2352x1568px · 45-degree field of view.
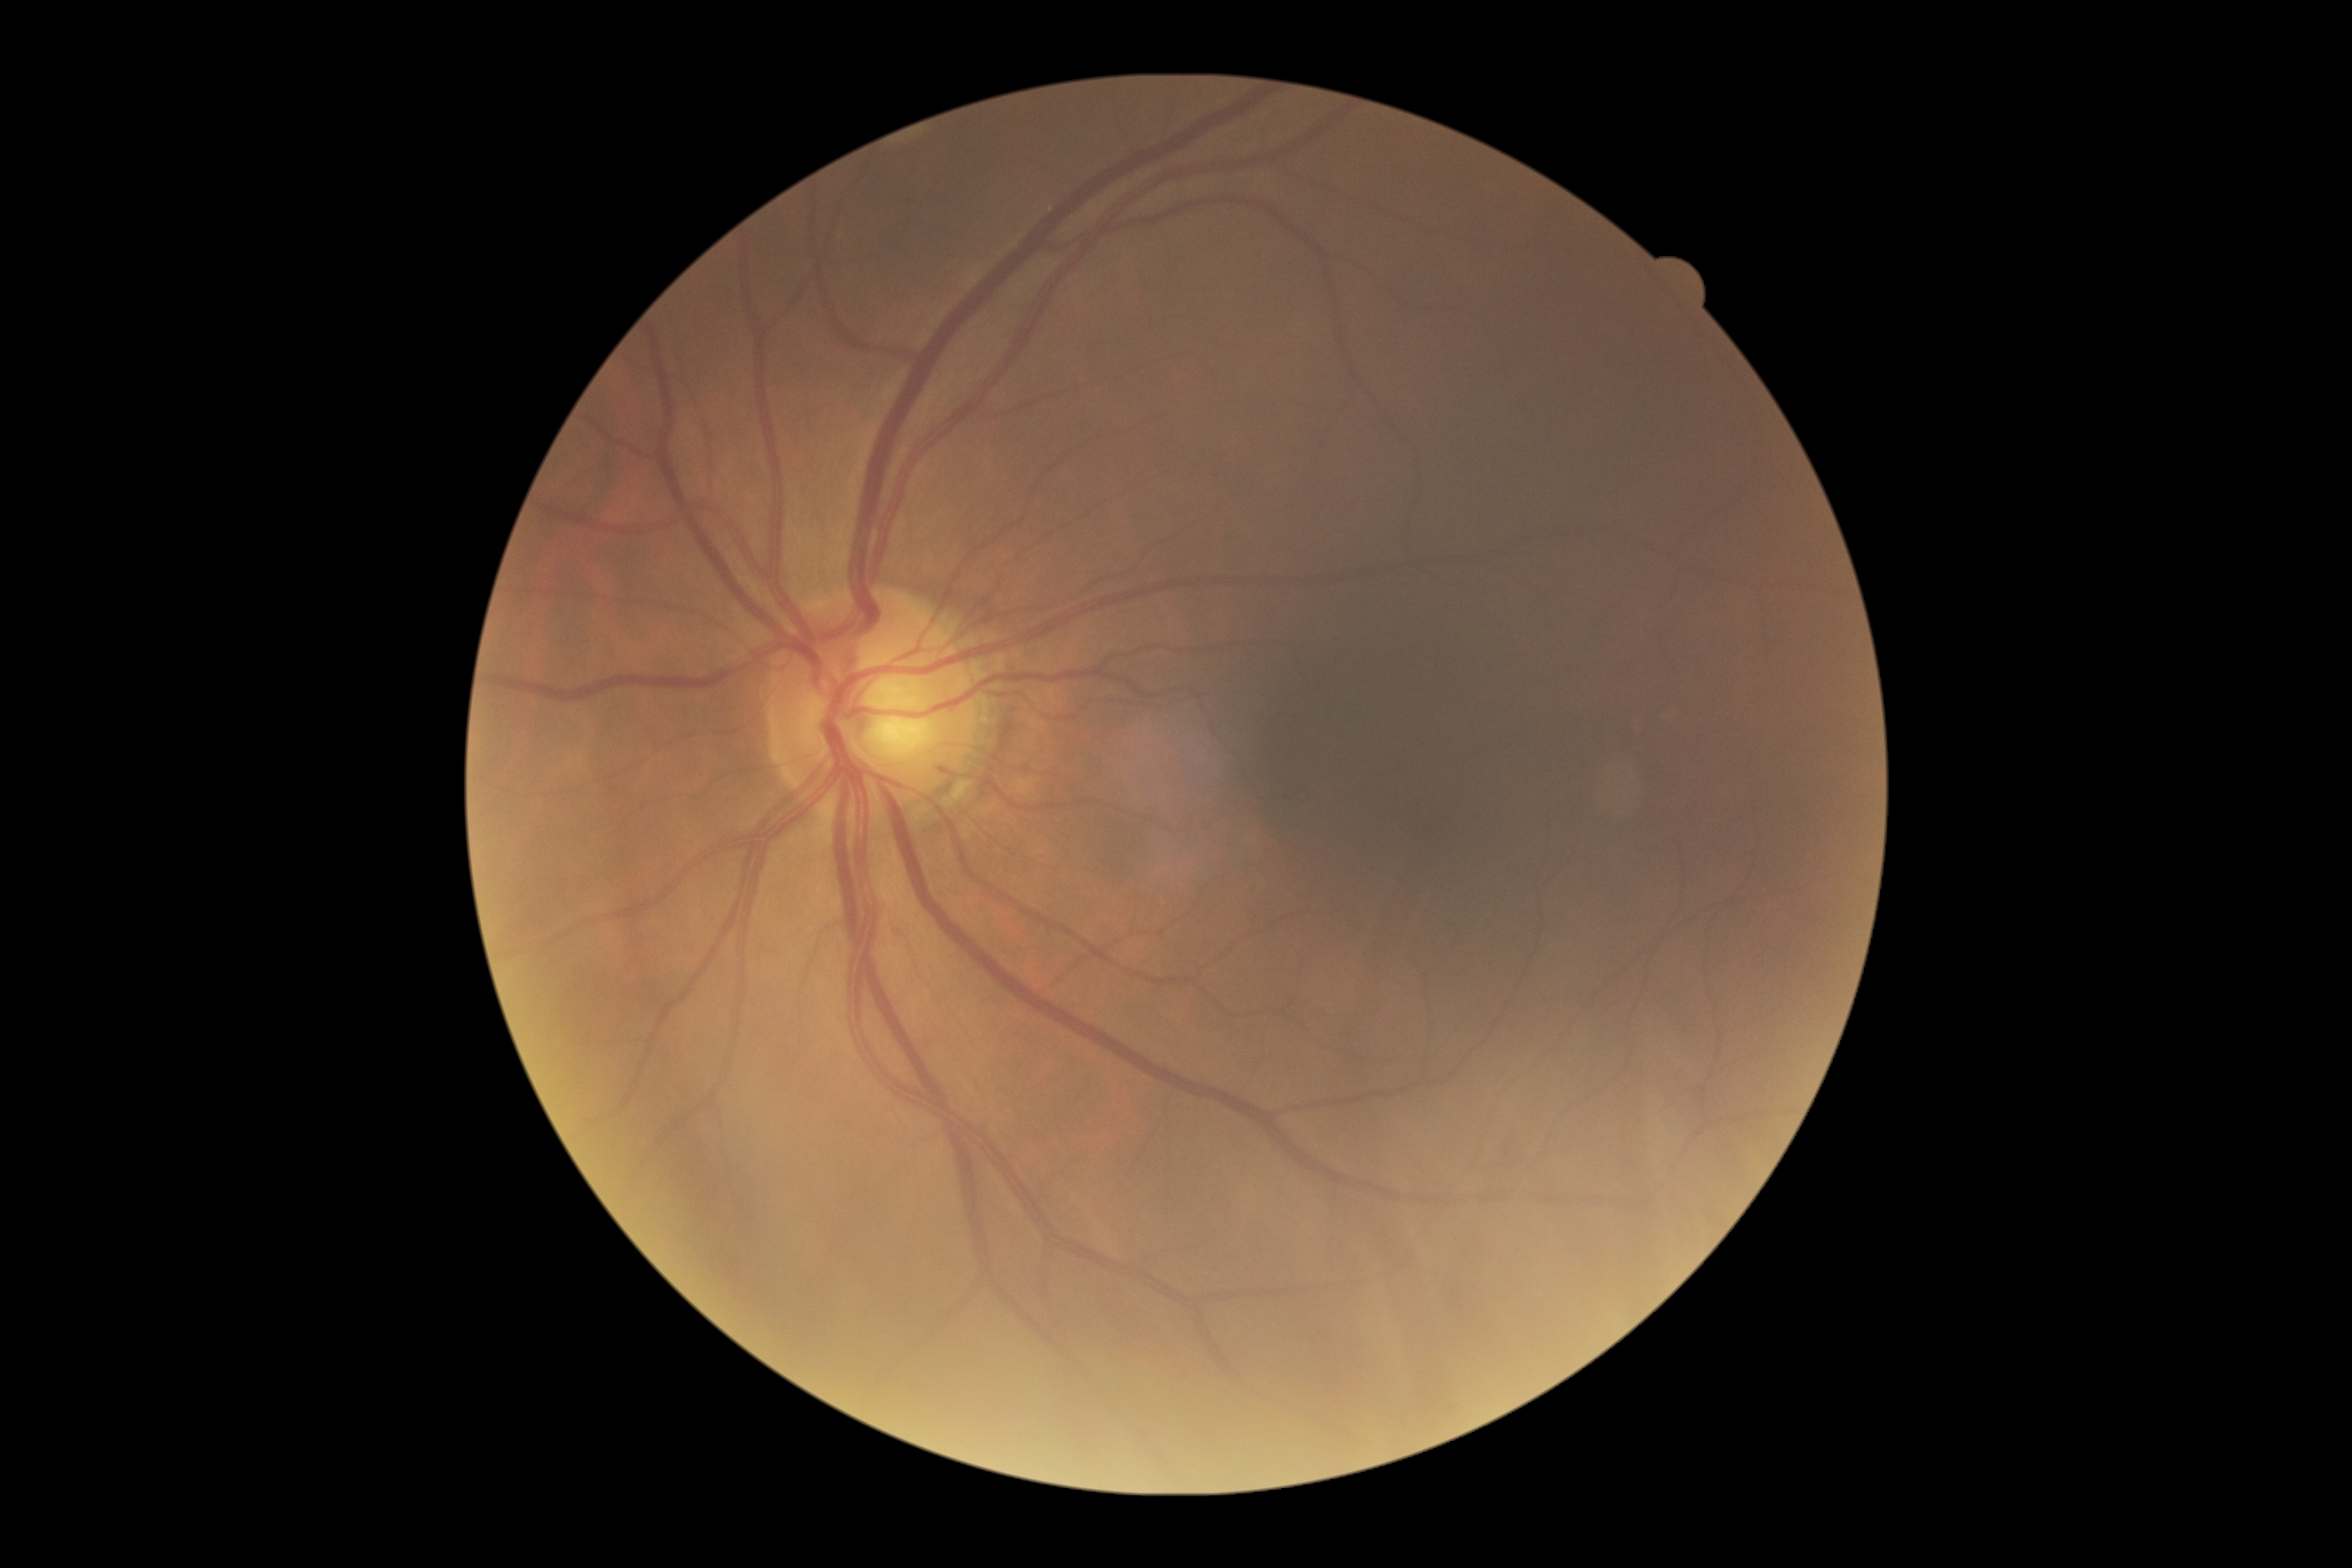 DR severity = grade 0 (no apparent retinopathy)